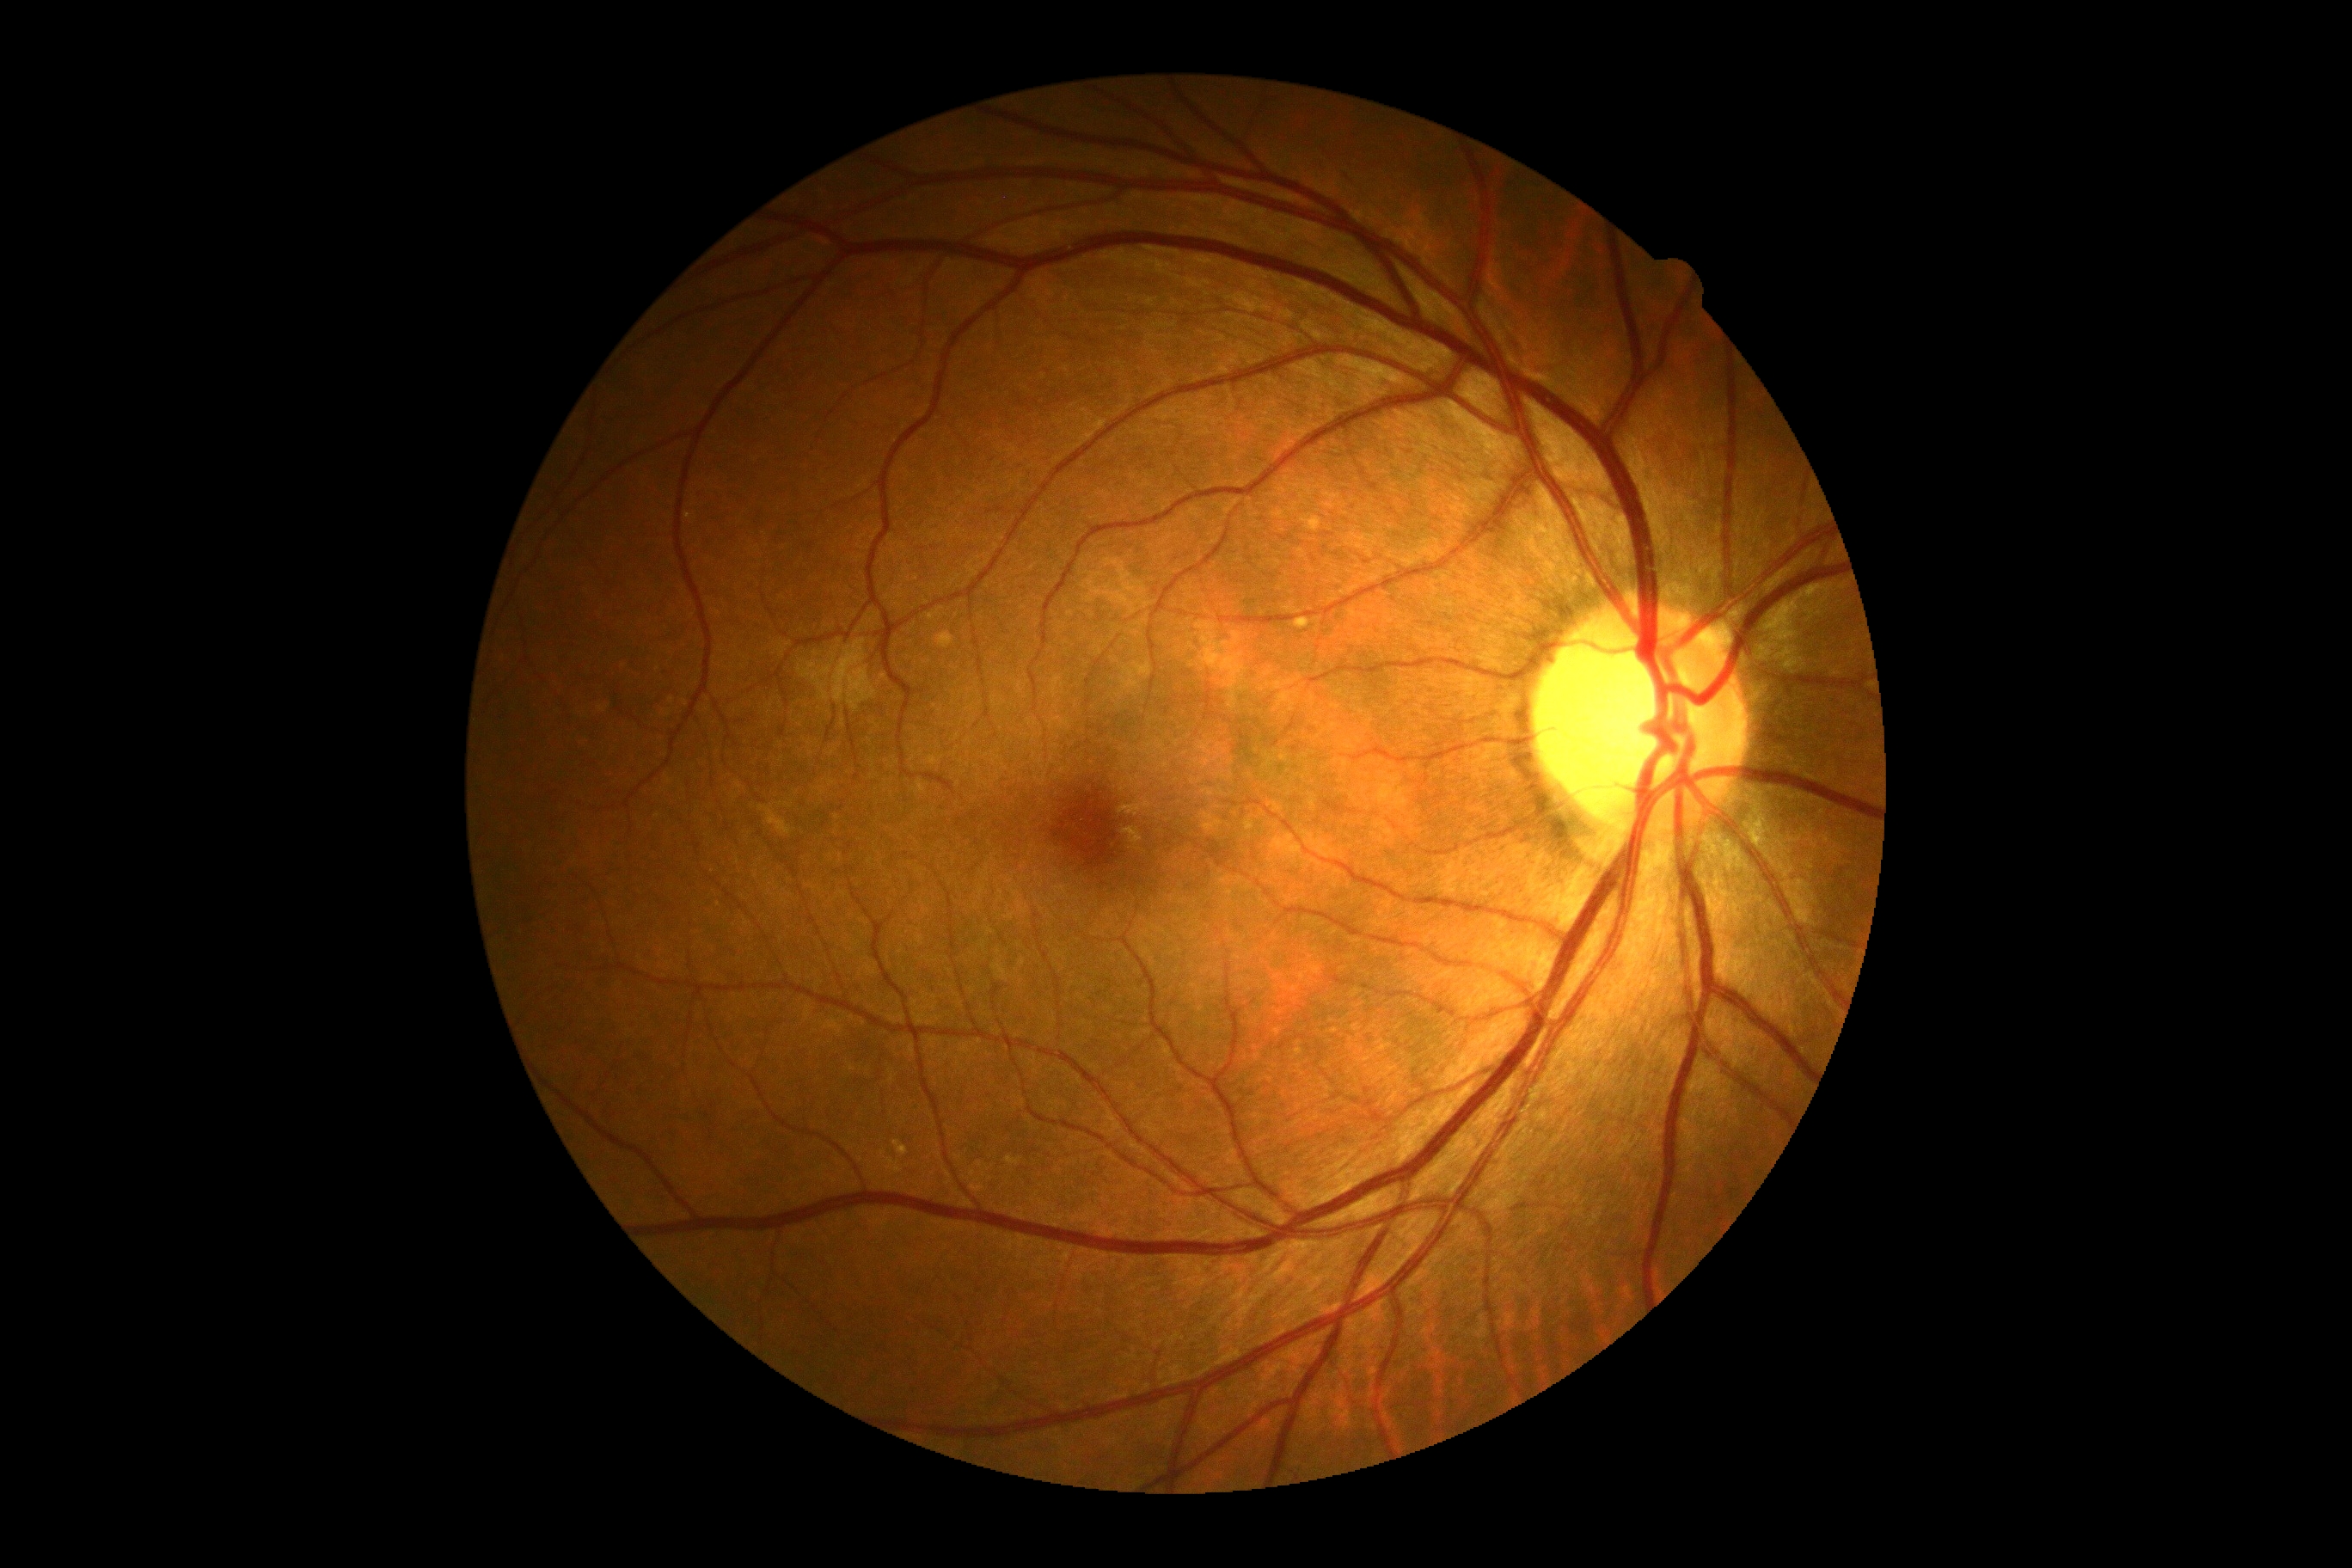

DR is 0/4.